Nonmydriatic fundus photograph. 848 by 848 pixels — 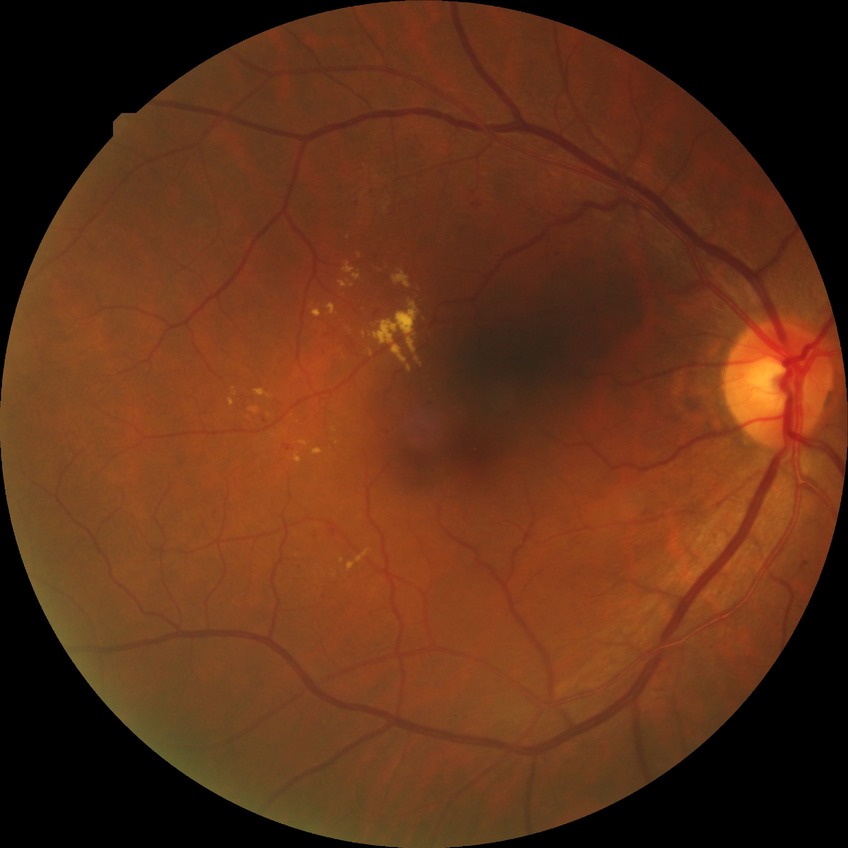
Davis DR grade: SDR.